45-degree field of view, without pupil dilation
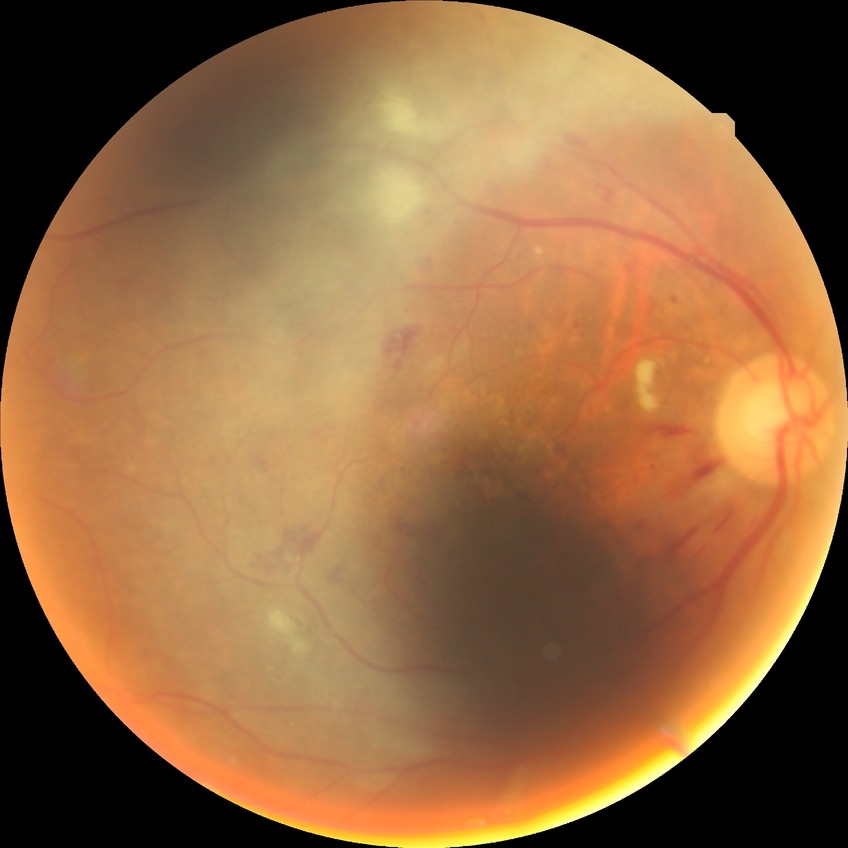
Davis grading: pre-proliferative diabetic retinopathy.